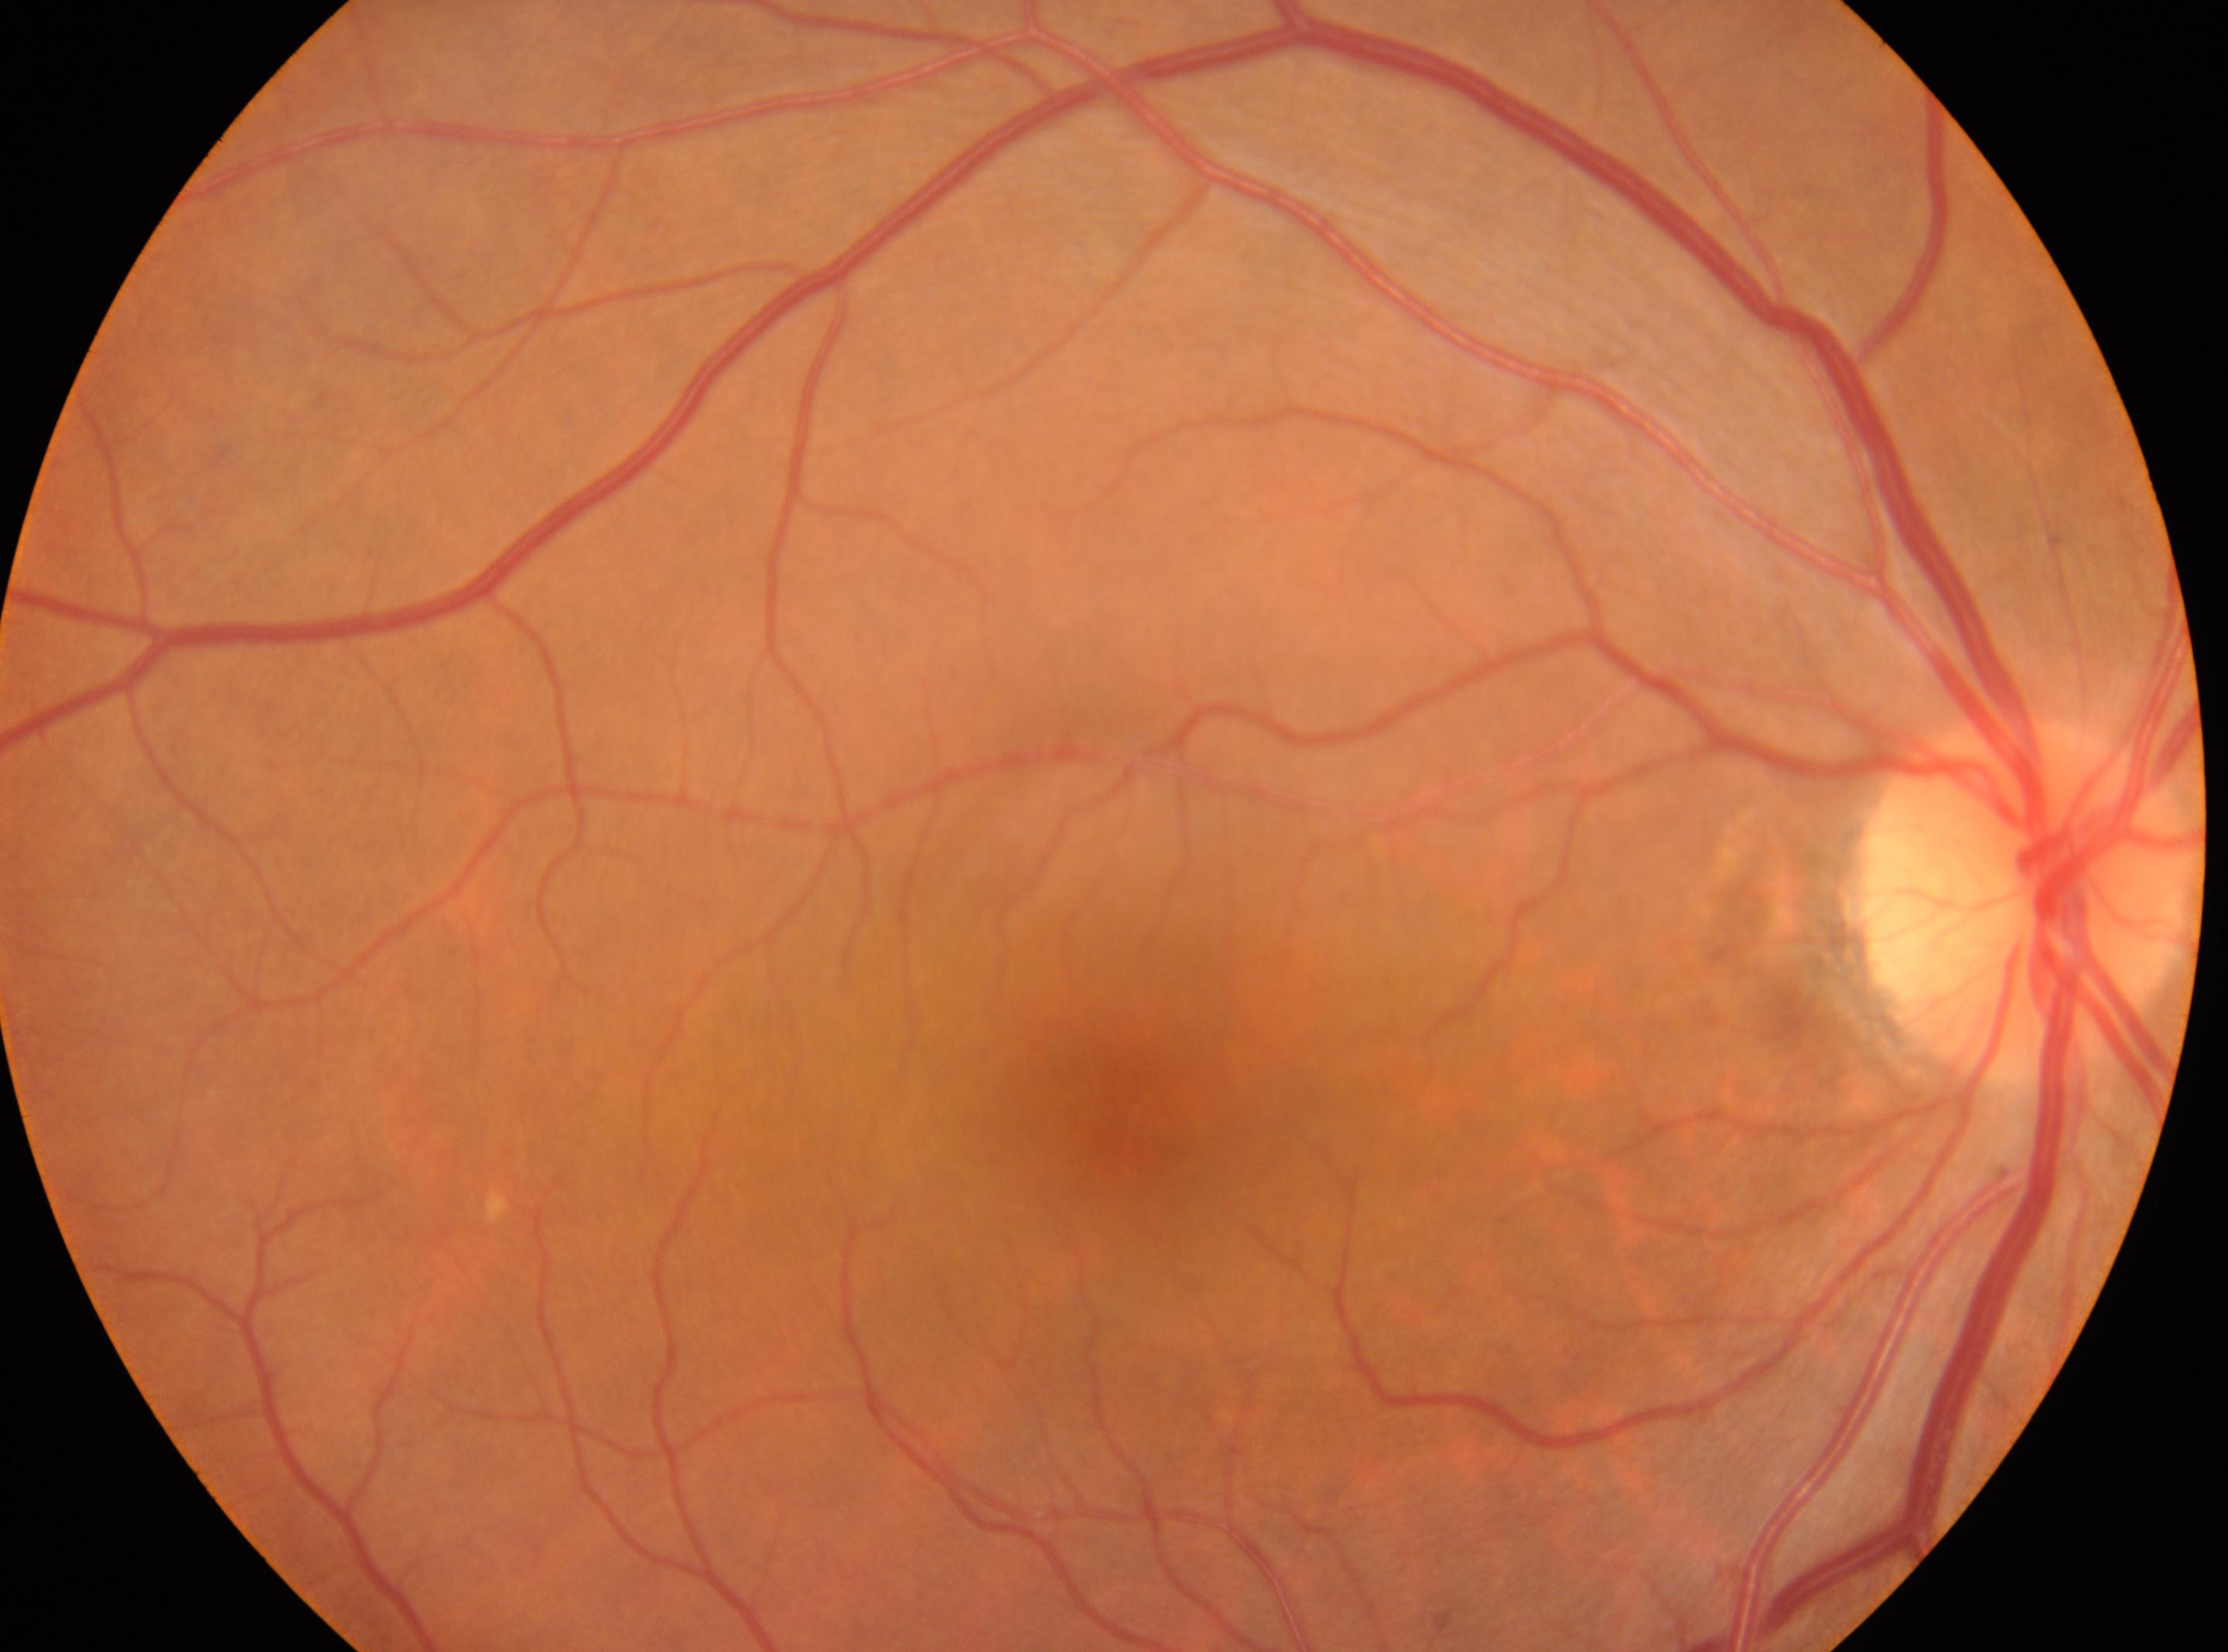
Fovea: (1123, 1097).
This is the right eye.
Optic disc located at (2025, 895).
Diabetic retinopathy severity is no apparent diabetic retinopathy (grade 0).
No diabetic retinopathy identified.